Fundus photo, 2089 by 1764 pixels — 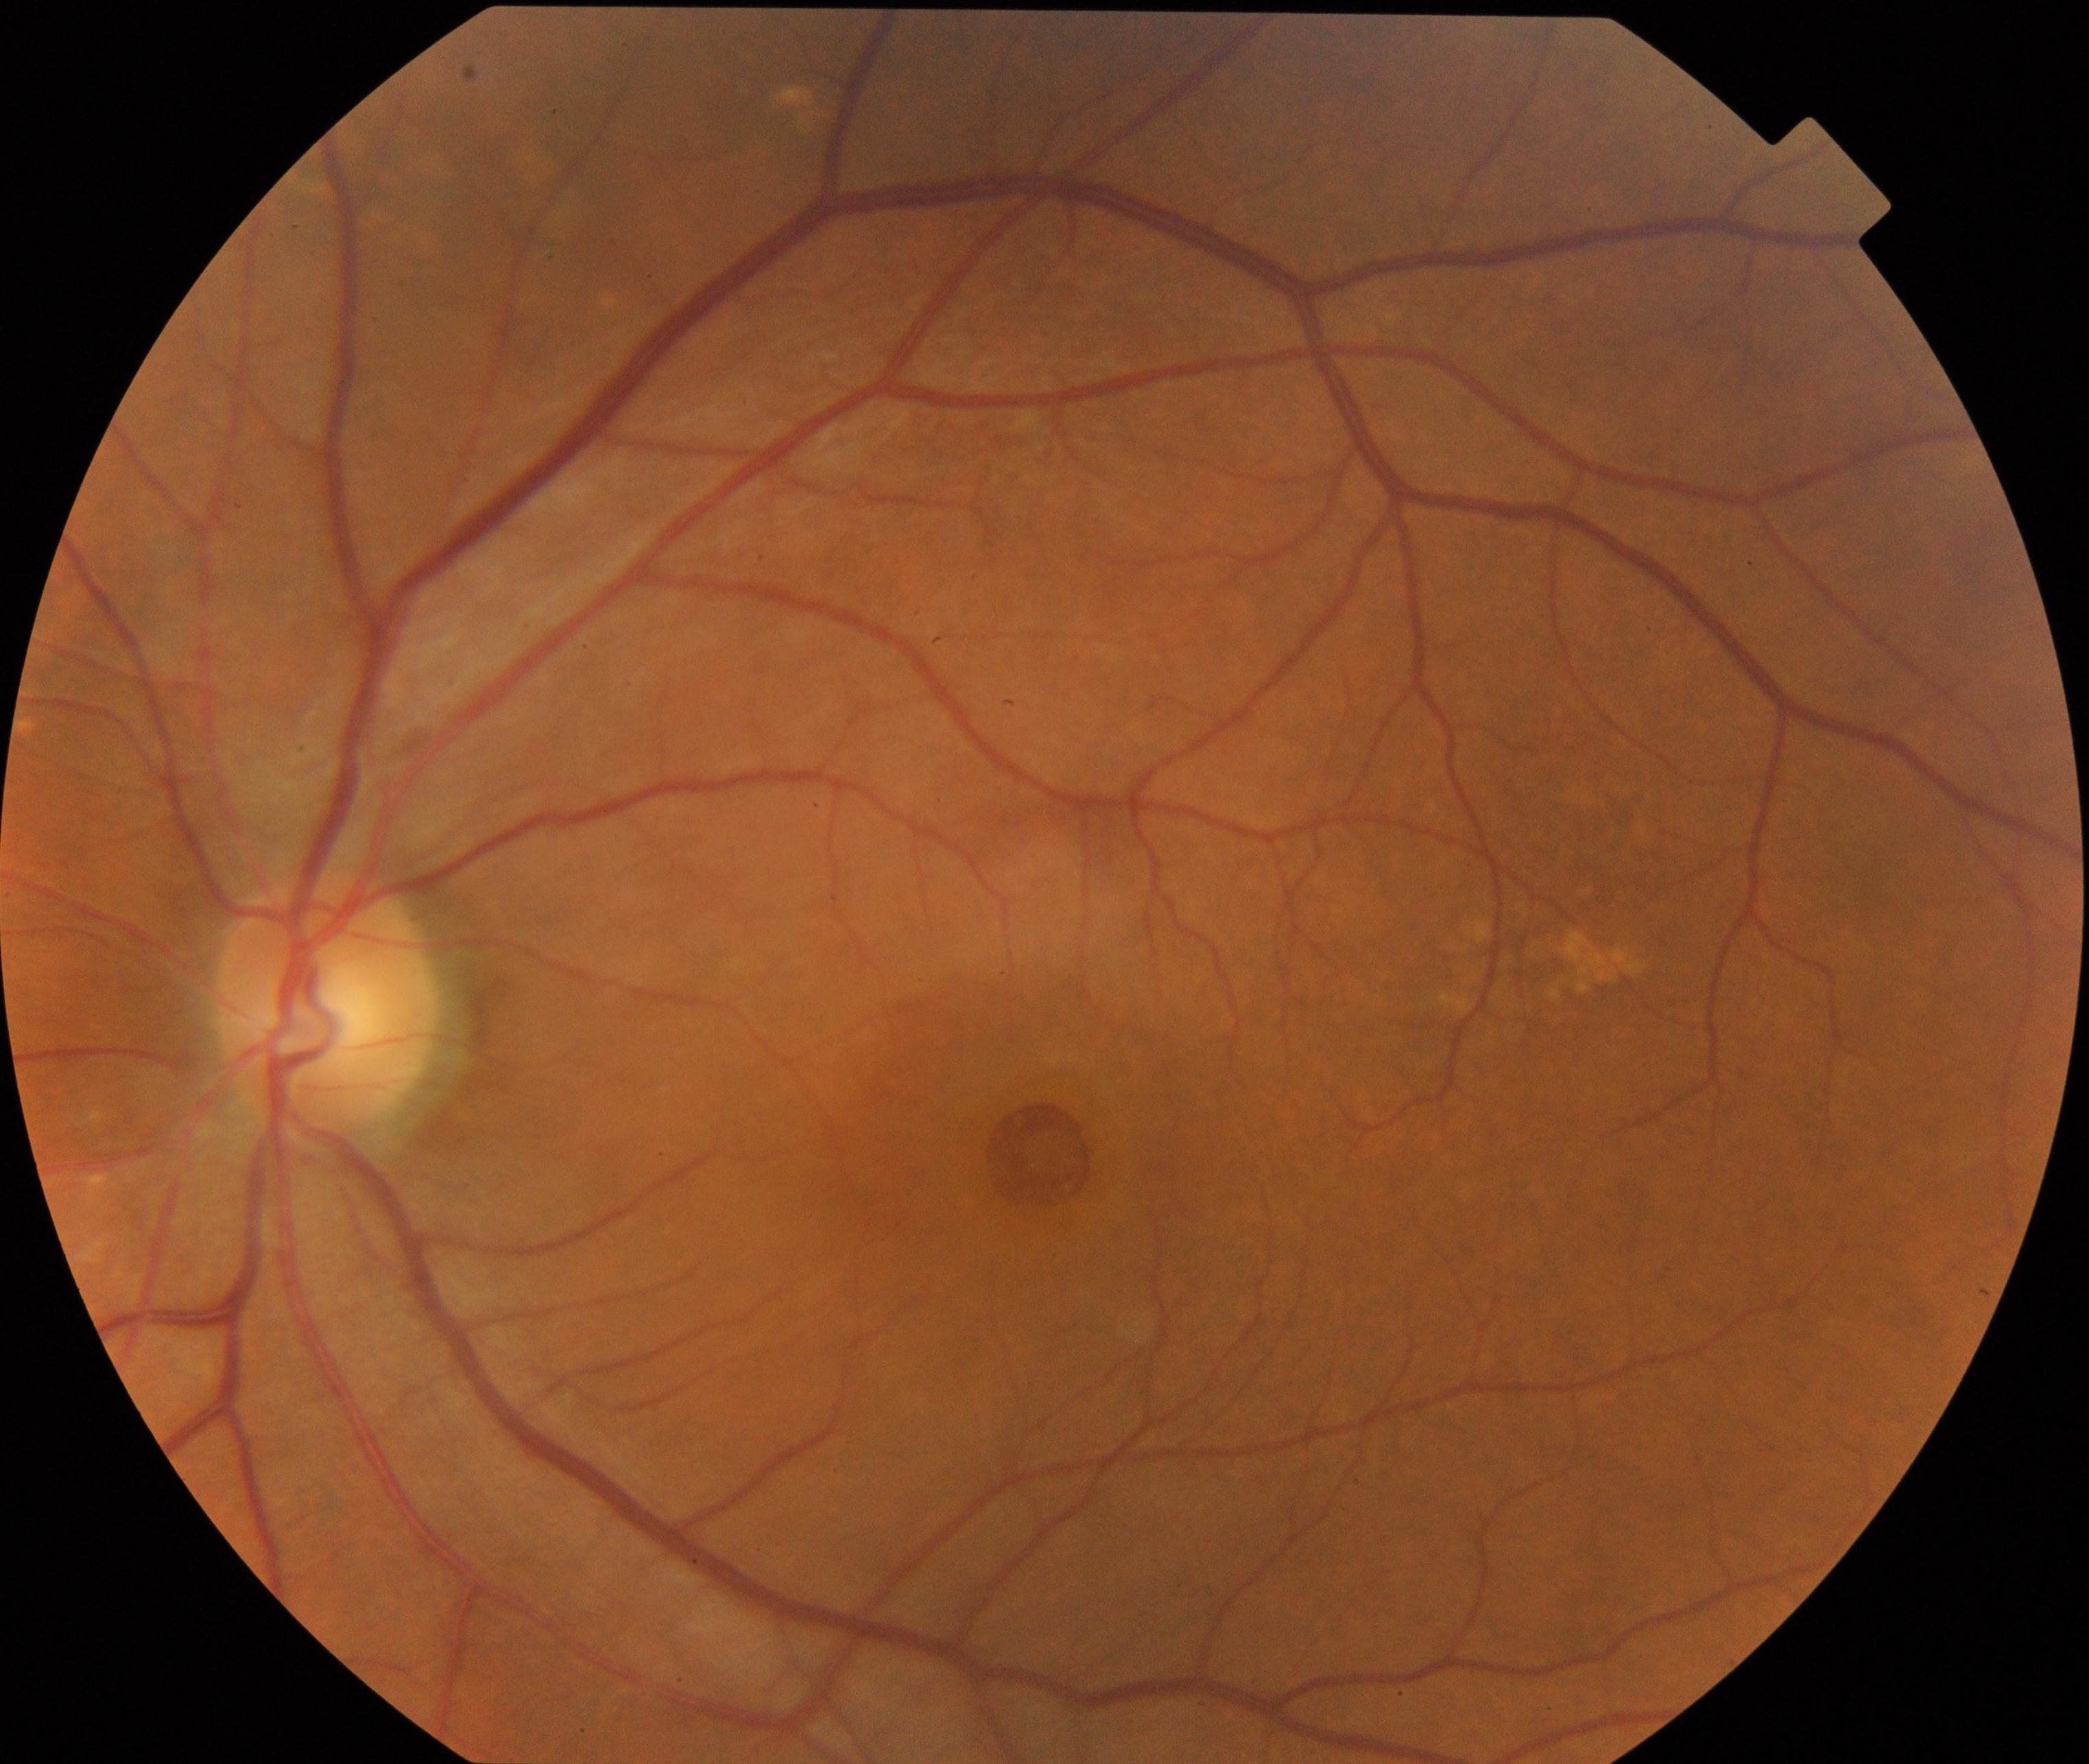 Findings consistent with macular hole (MH). Defined by central foveal defect, round or oval, sometimes with multiple yellow deposits within the crater or a surrounding cuff of subretinal fluid.